45° field of view:
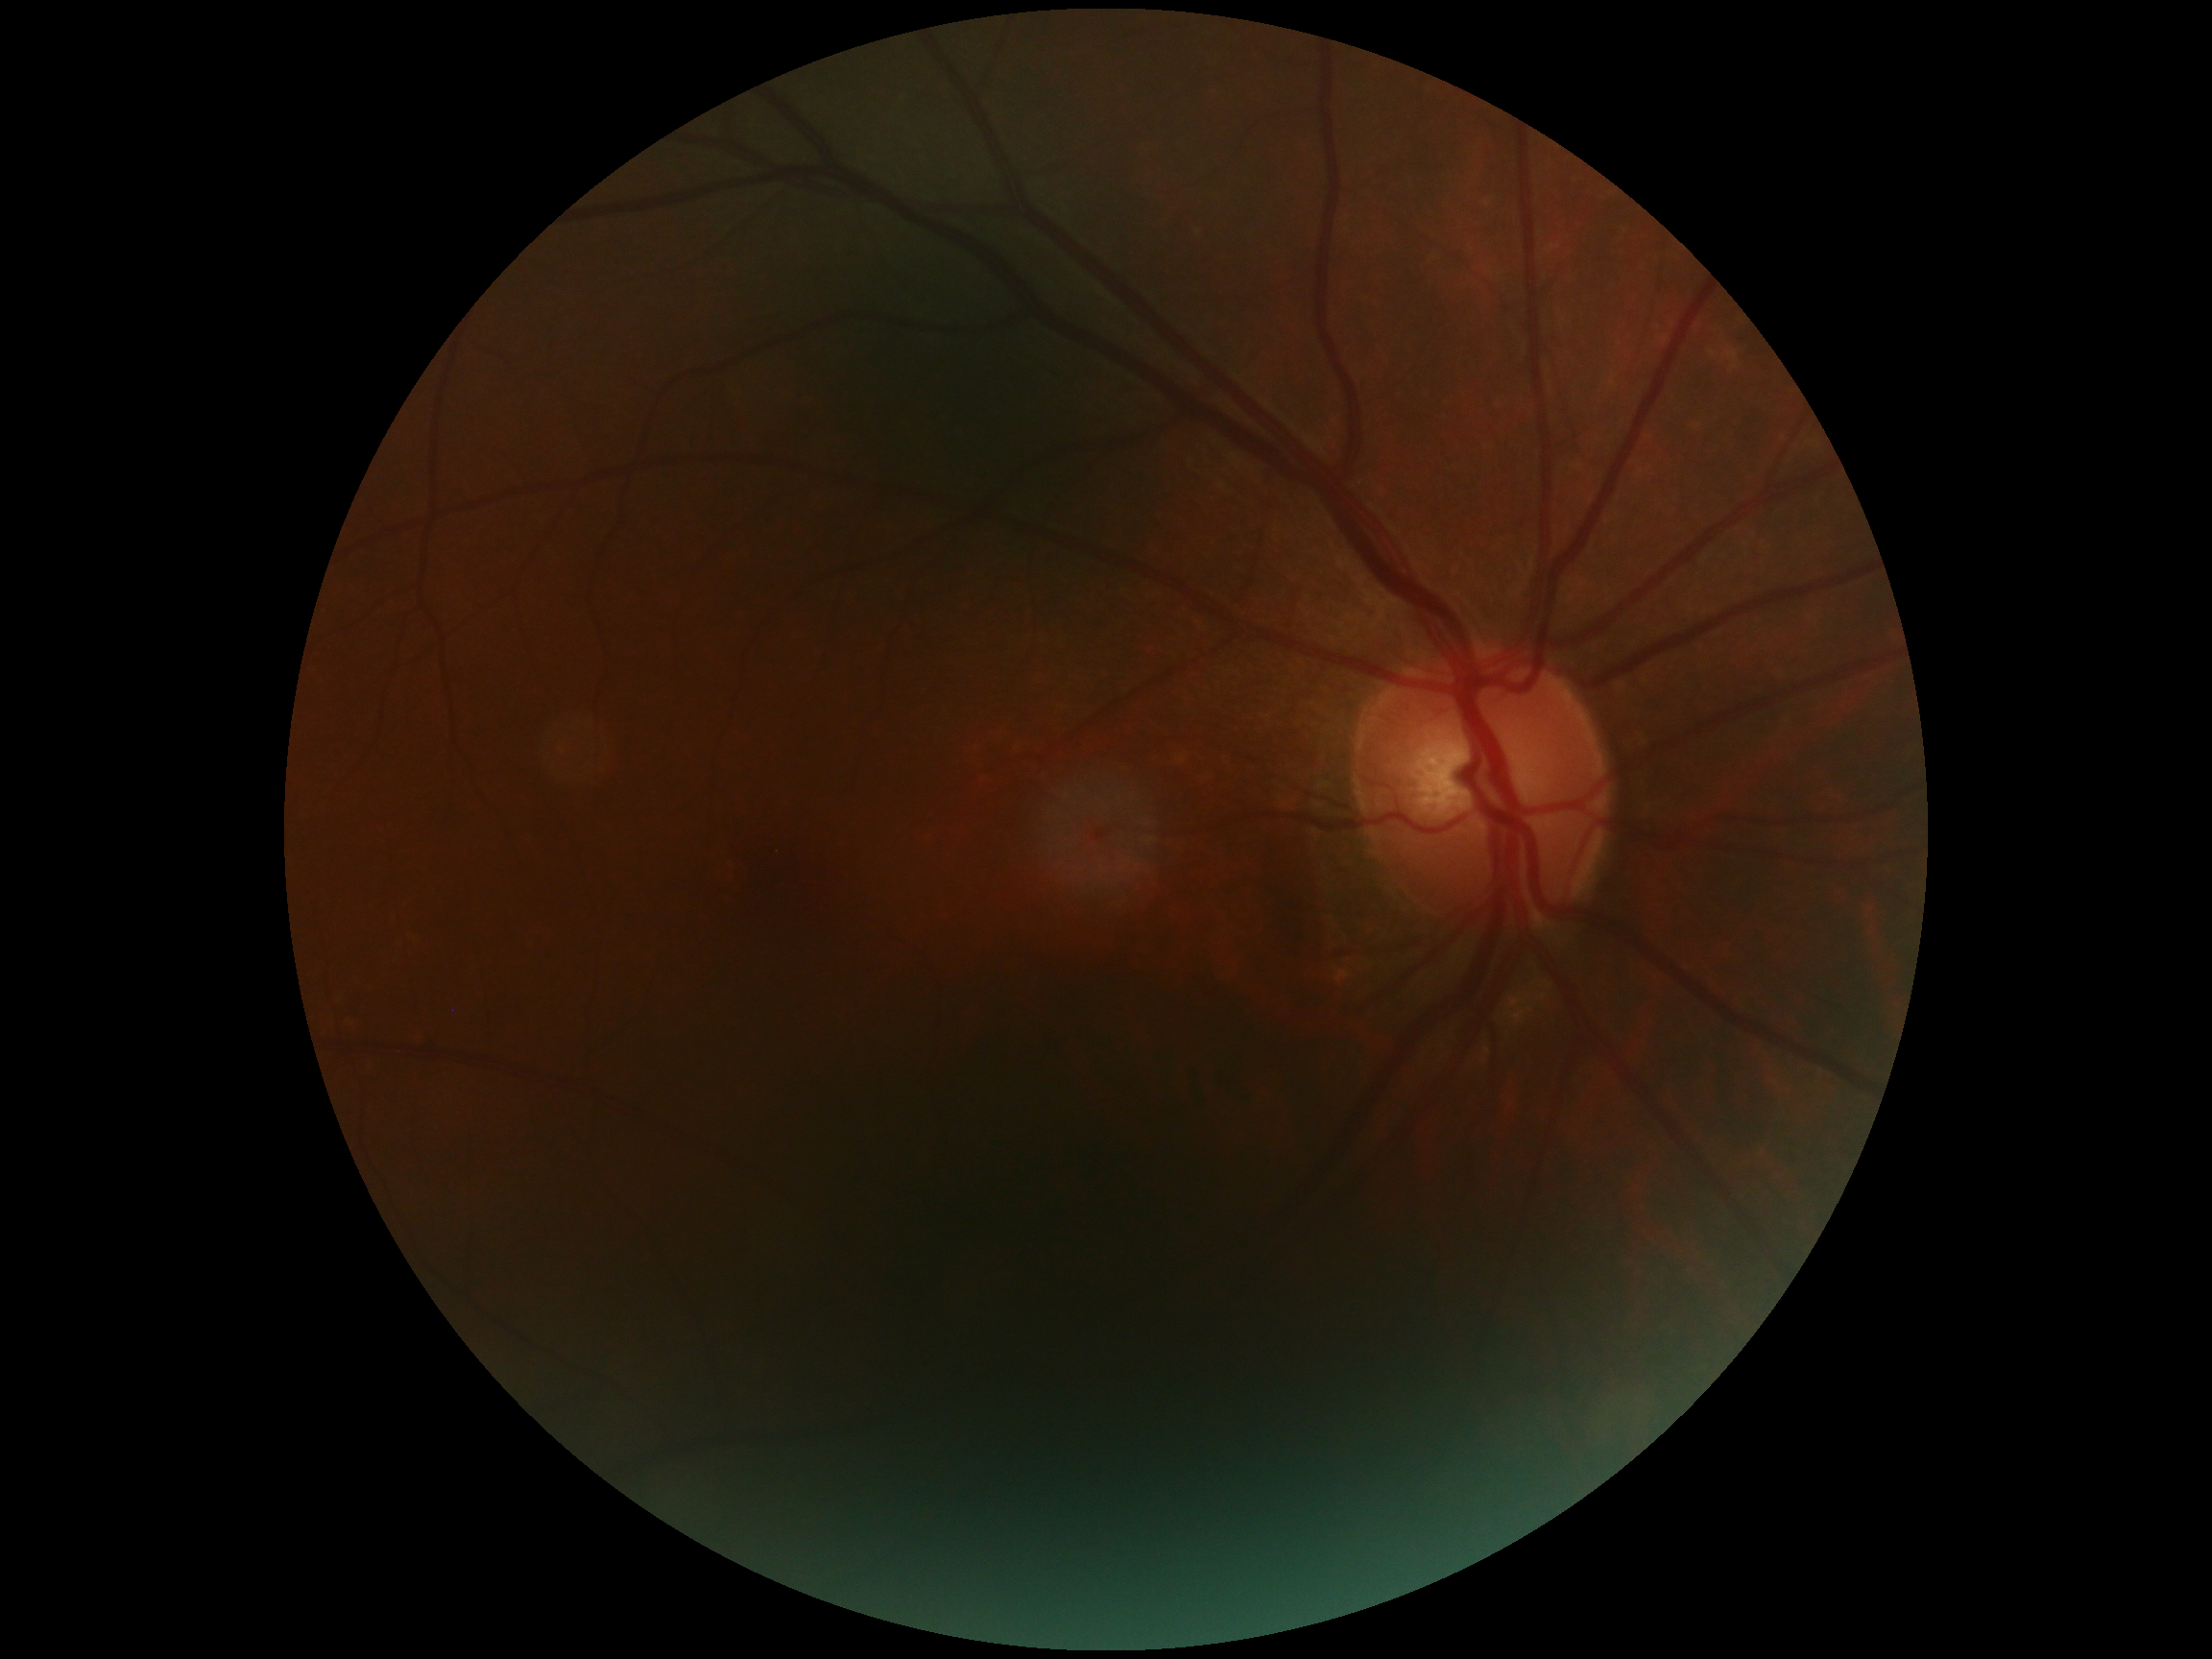 Diabetic retinopathy is grade 0.
No signs of diabetic retinopathy.